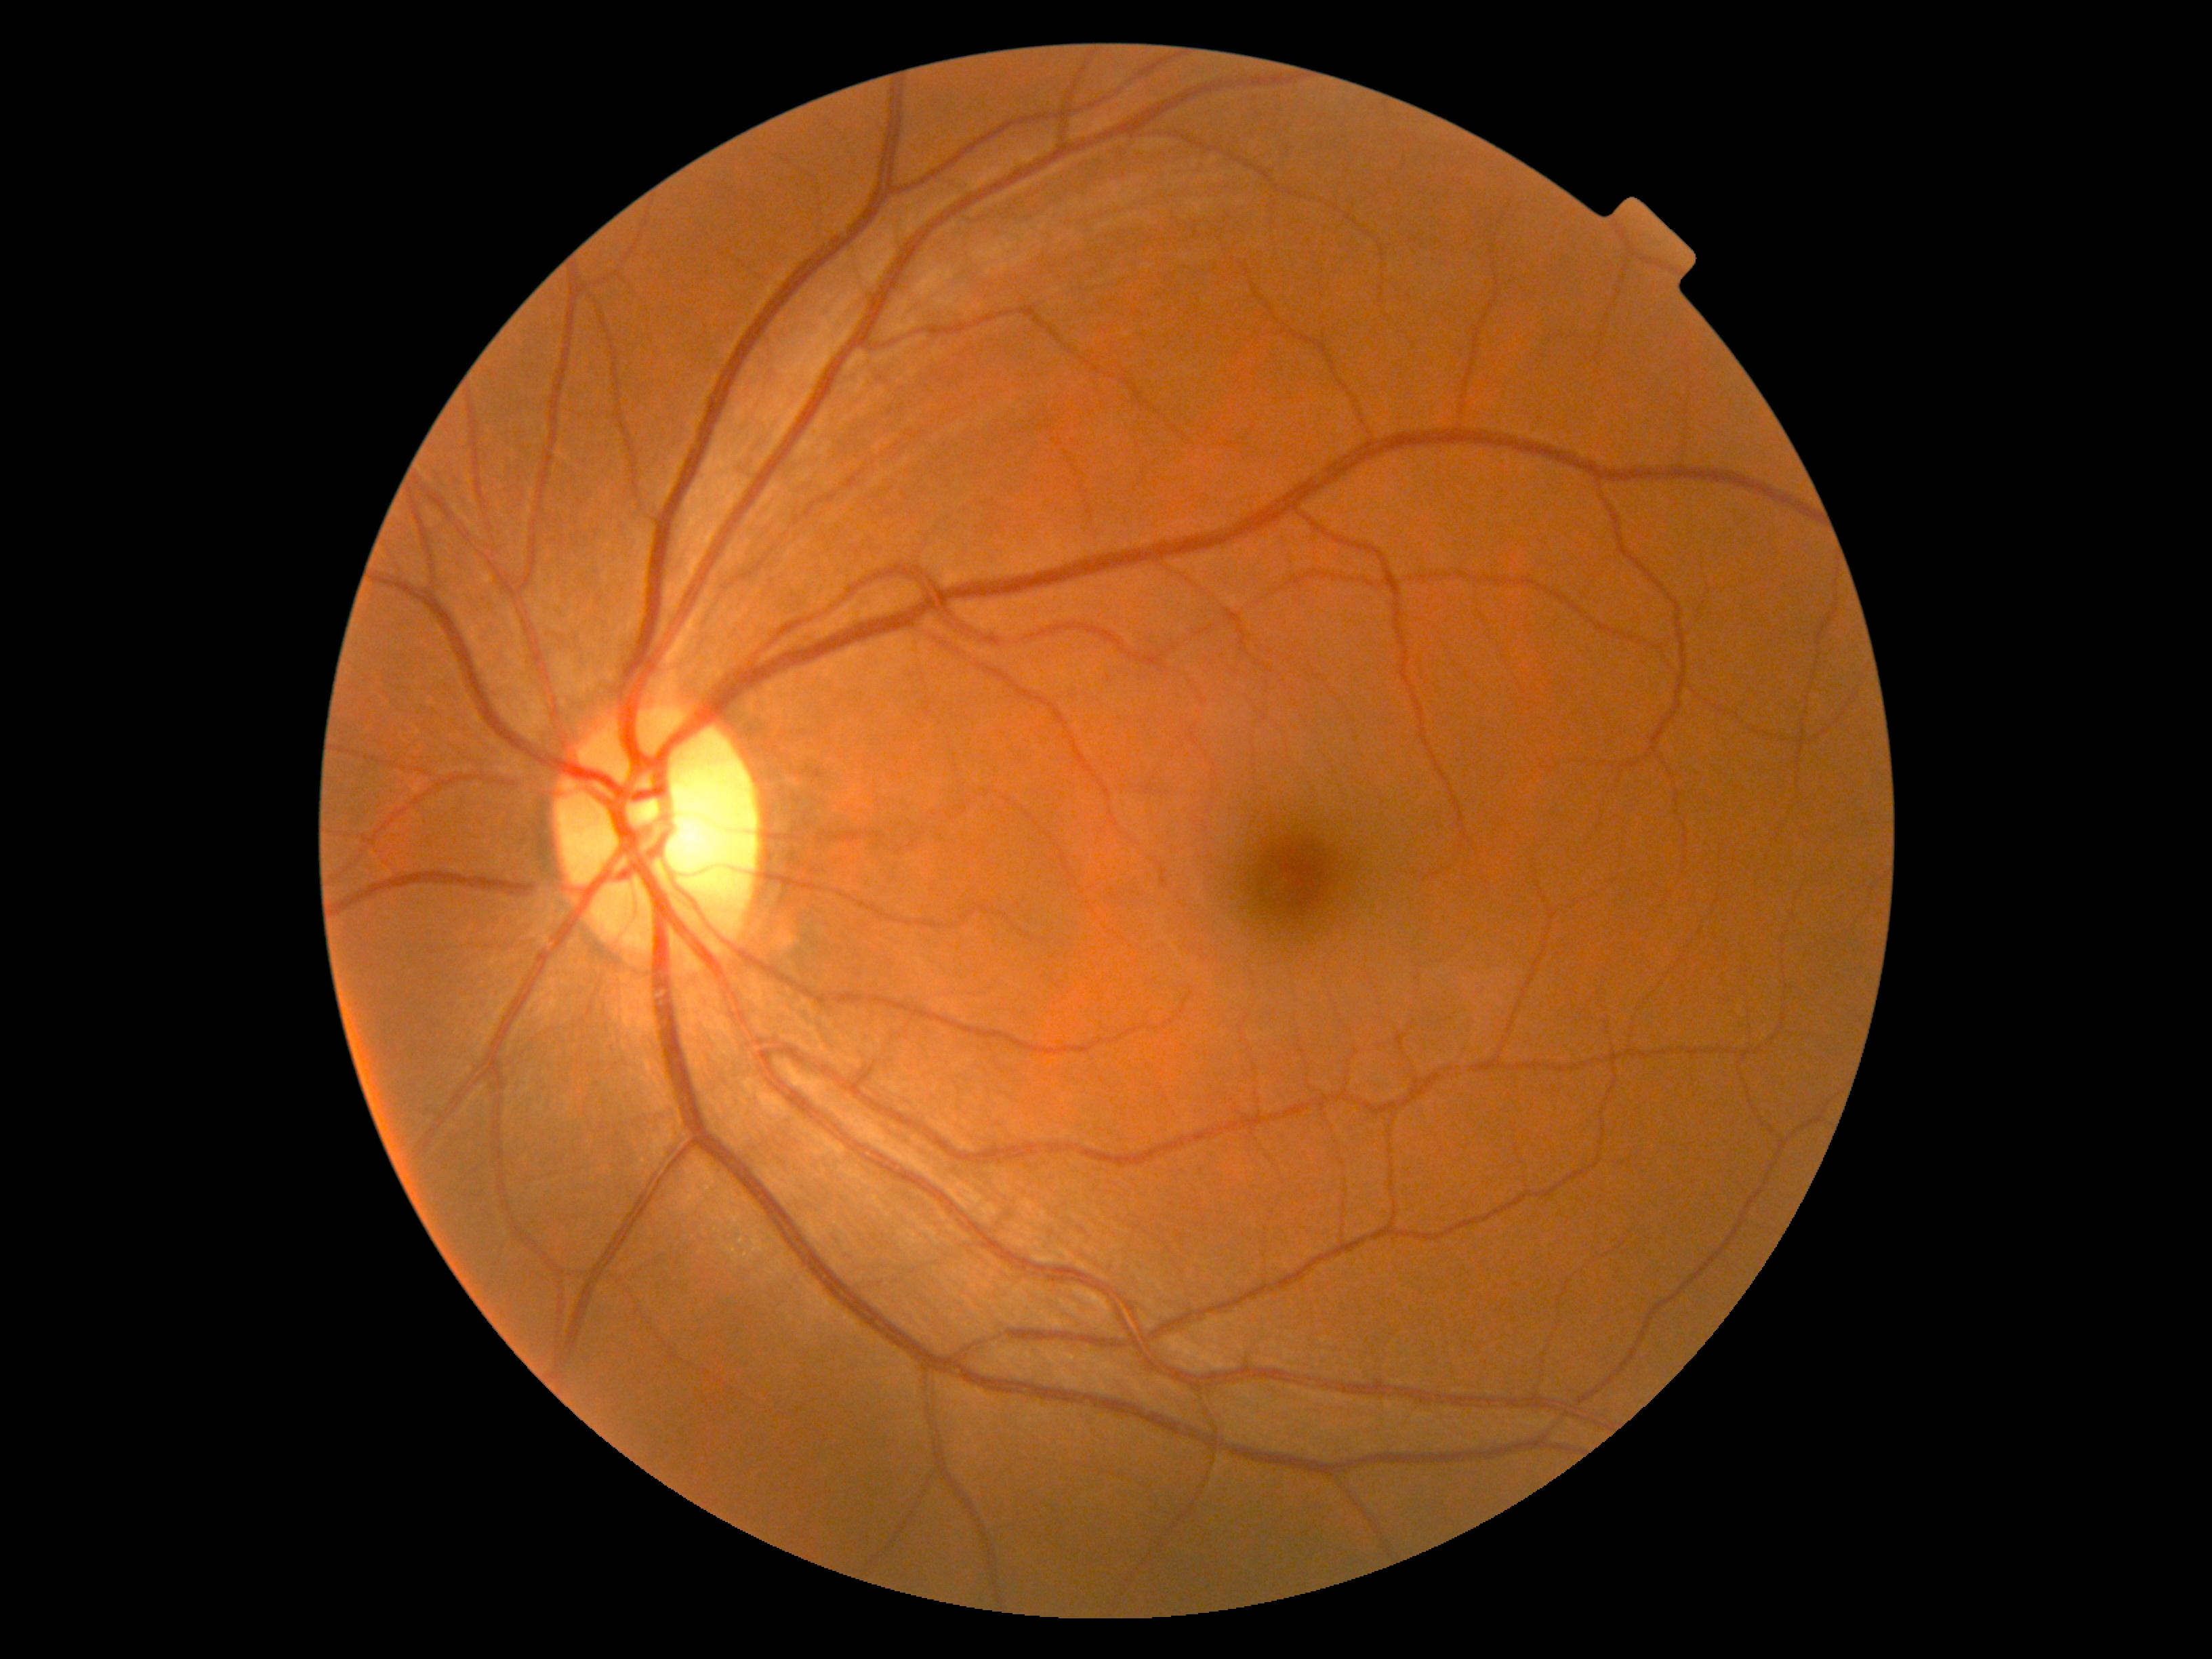
DR is grade 0.